Tabletop color fundus camera image · 45-degree field of view.
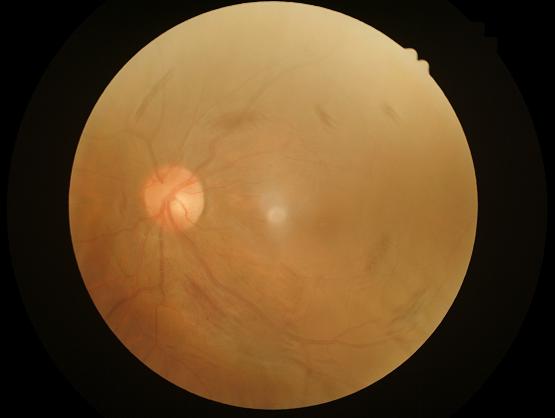

{
  "overall_quality": "inadequate for clinical interpretation",
  "contrast": "low, vessels and details hard to distinguish",
  "illumination": "even and well-balanced",
  "clarity": "reduced sharpness with visible blur"
}